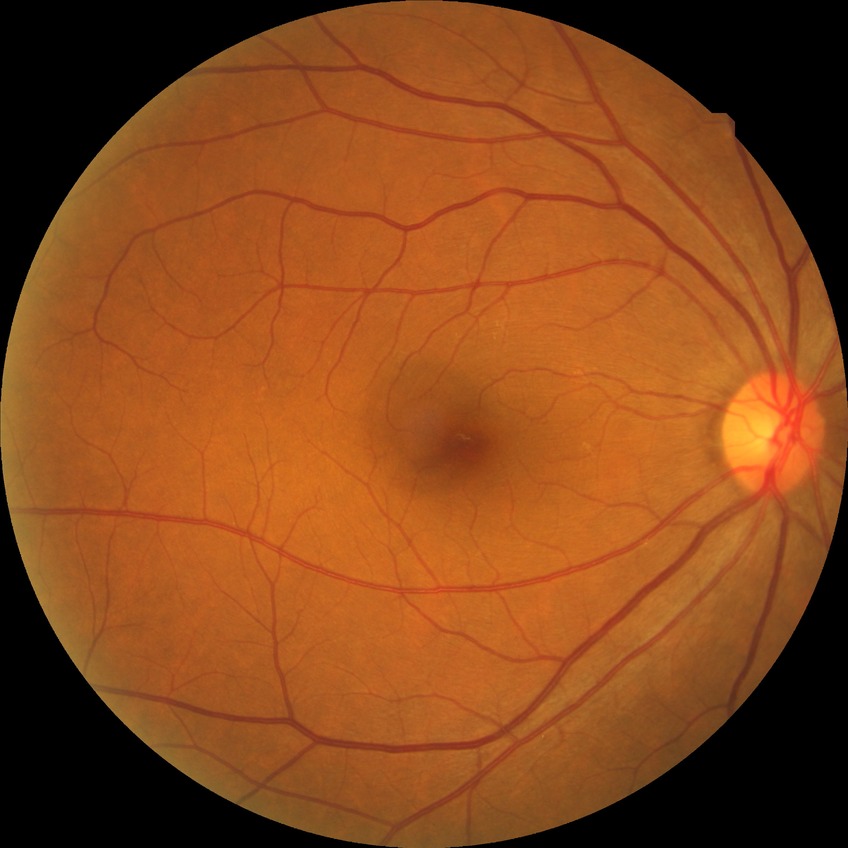 Findings:
- diabetic retinopathy (DR): NDR (no diabetic retinopathy)